Modified Davis grading
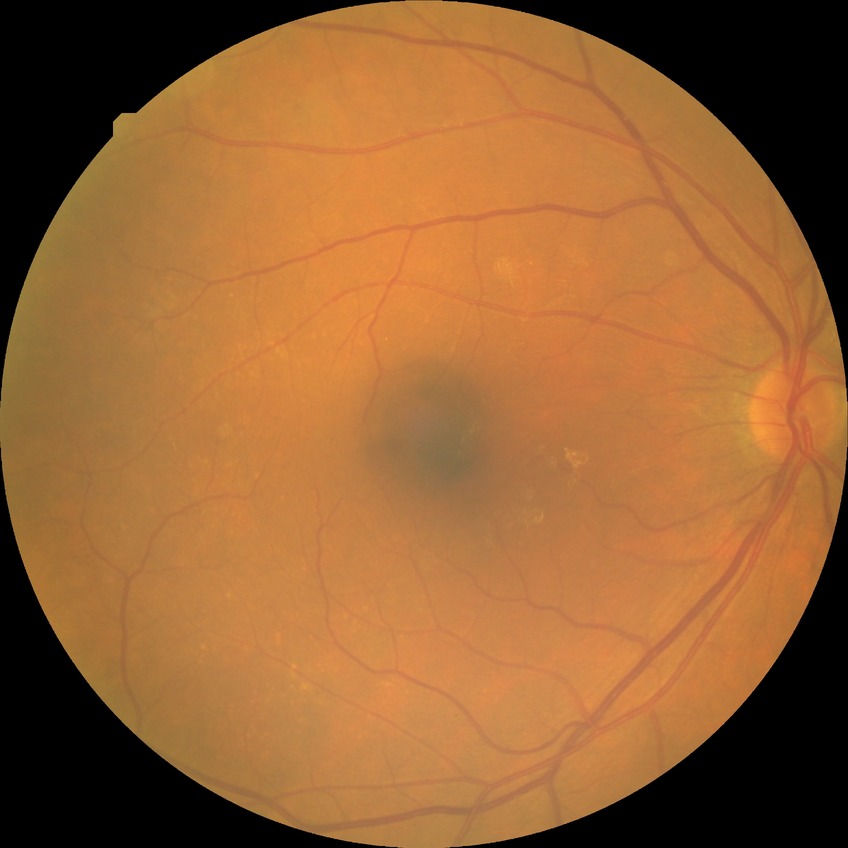
Assessment:
• diabetic retinopathy (DR): no diabetic retinopathy (NDR)